1924 x 1556 pixels; wide-field retinal mosaic image
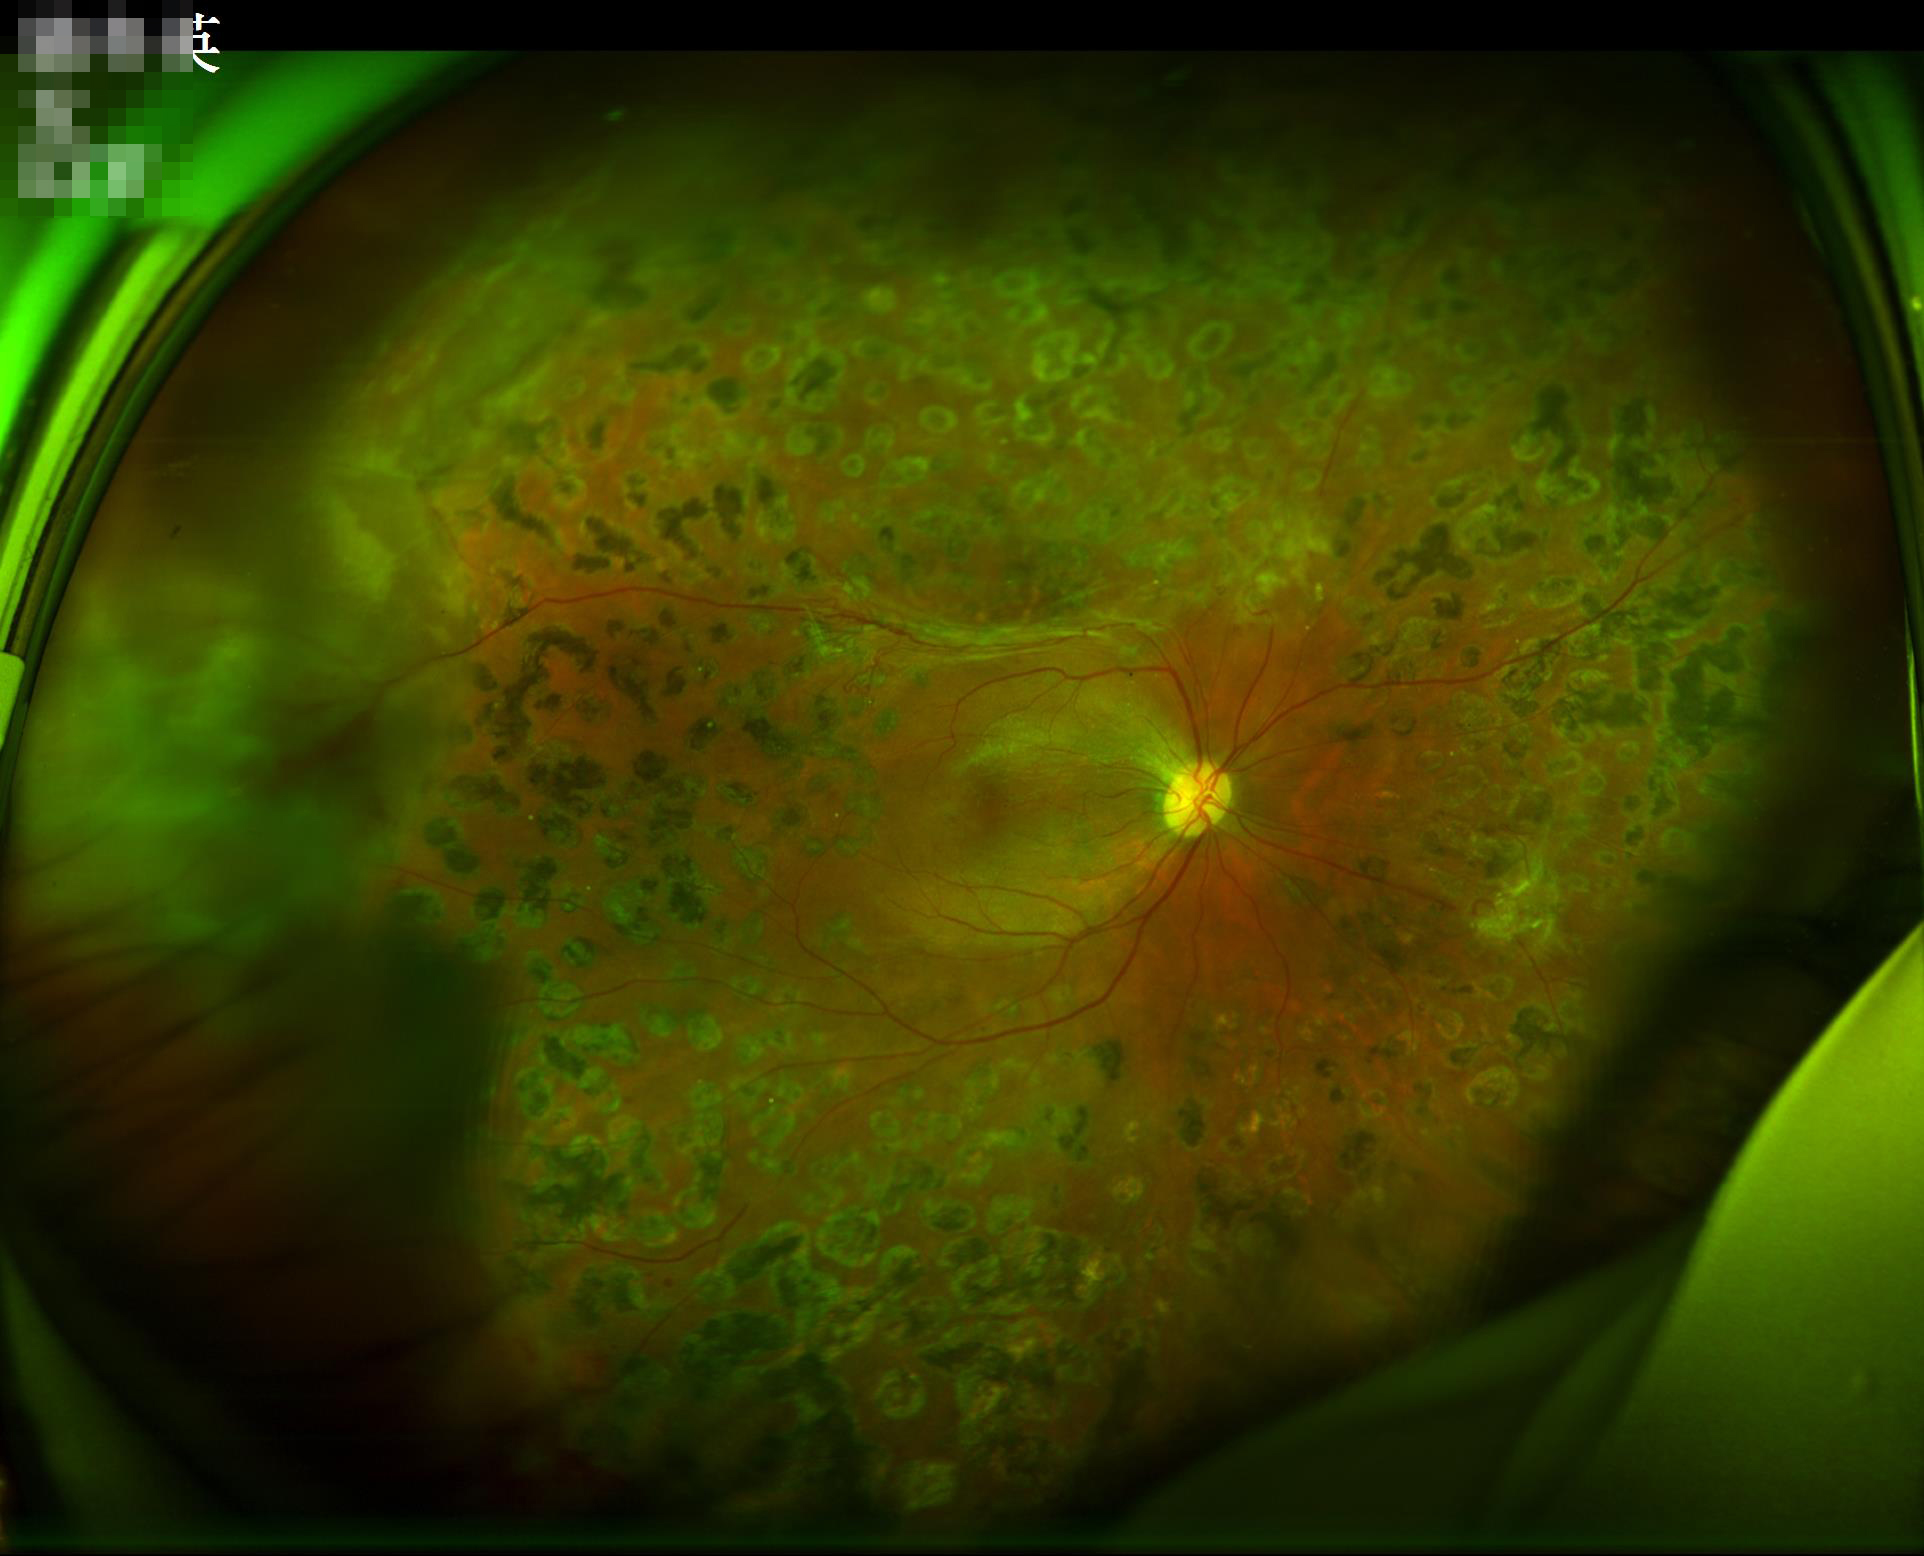
Illumination is uneven. Image is sharp throughout the field. Contrast is good. Overall quality is good and the image is gradable.